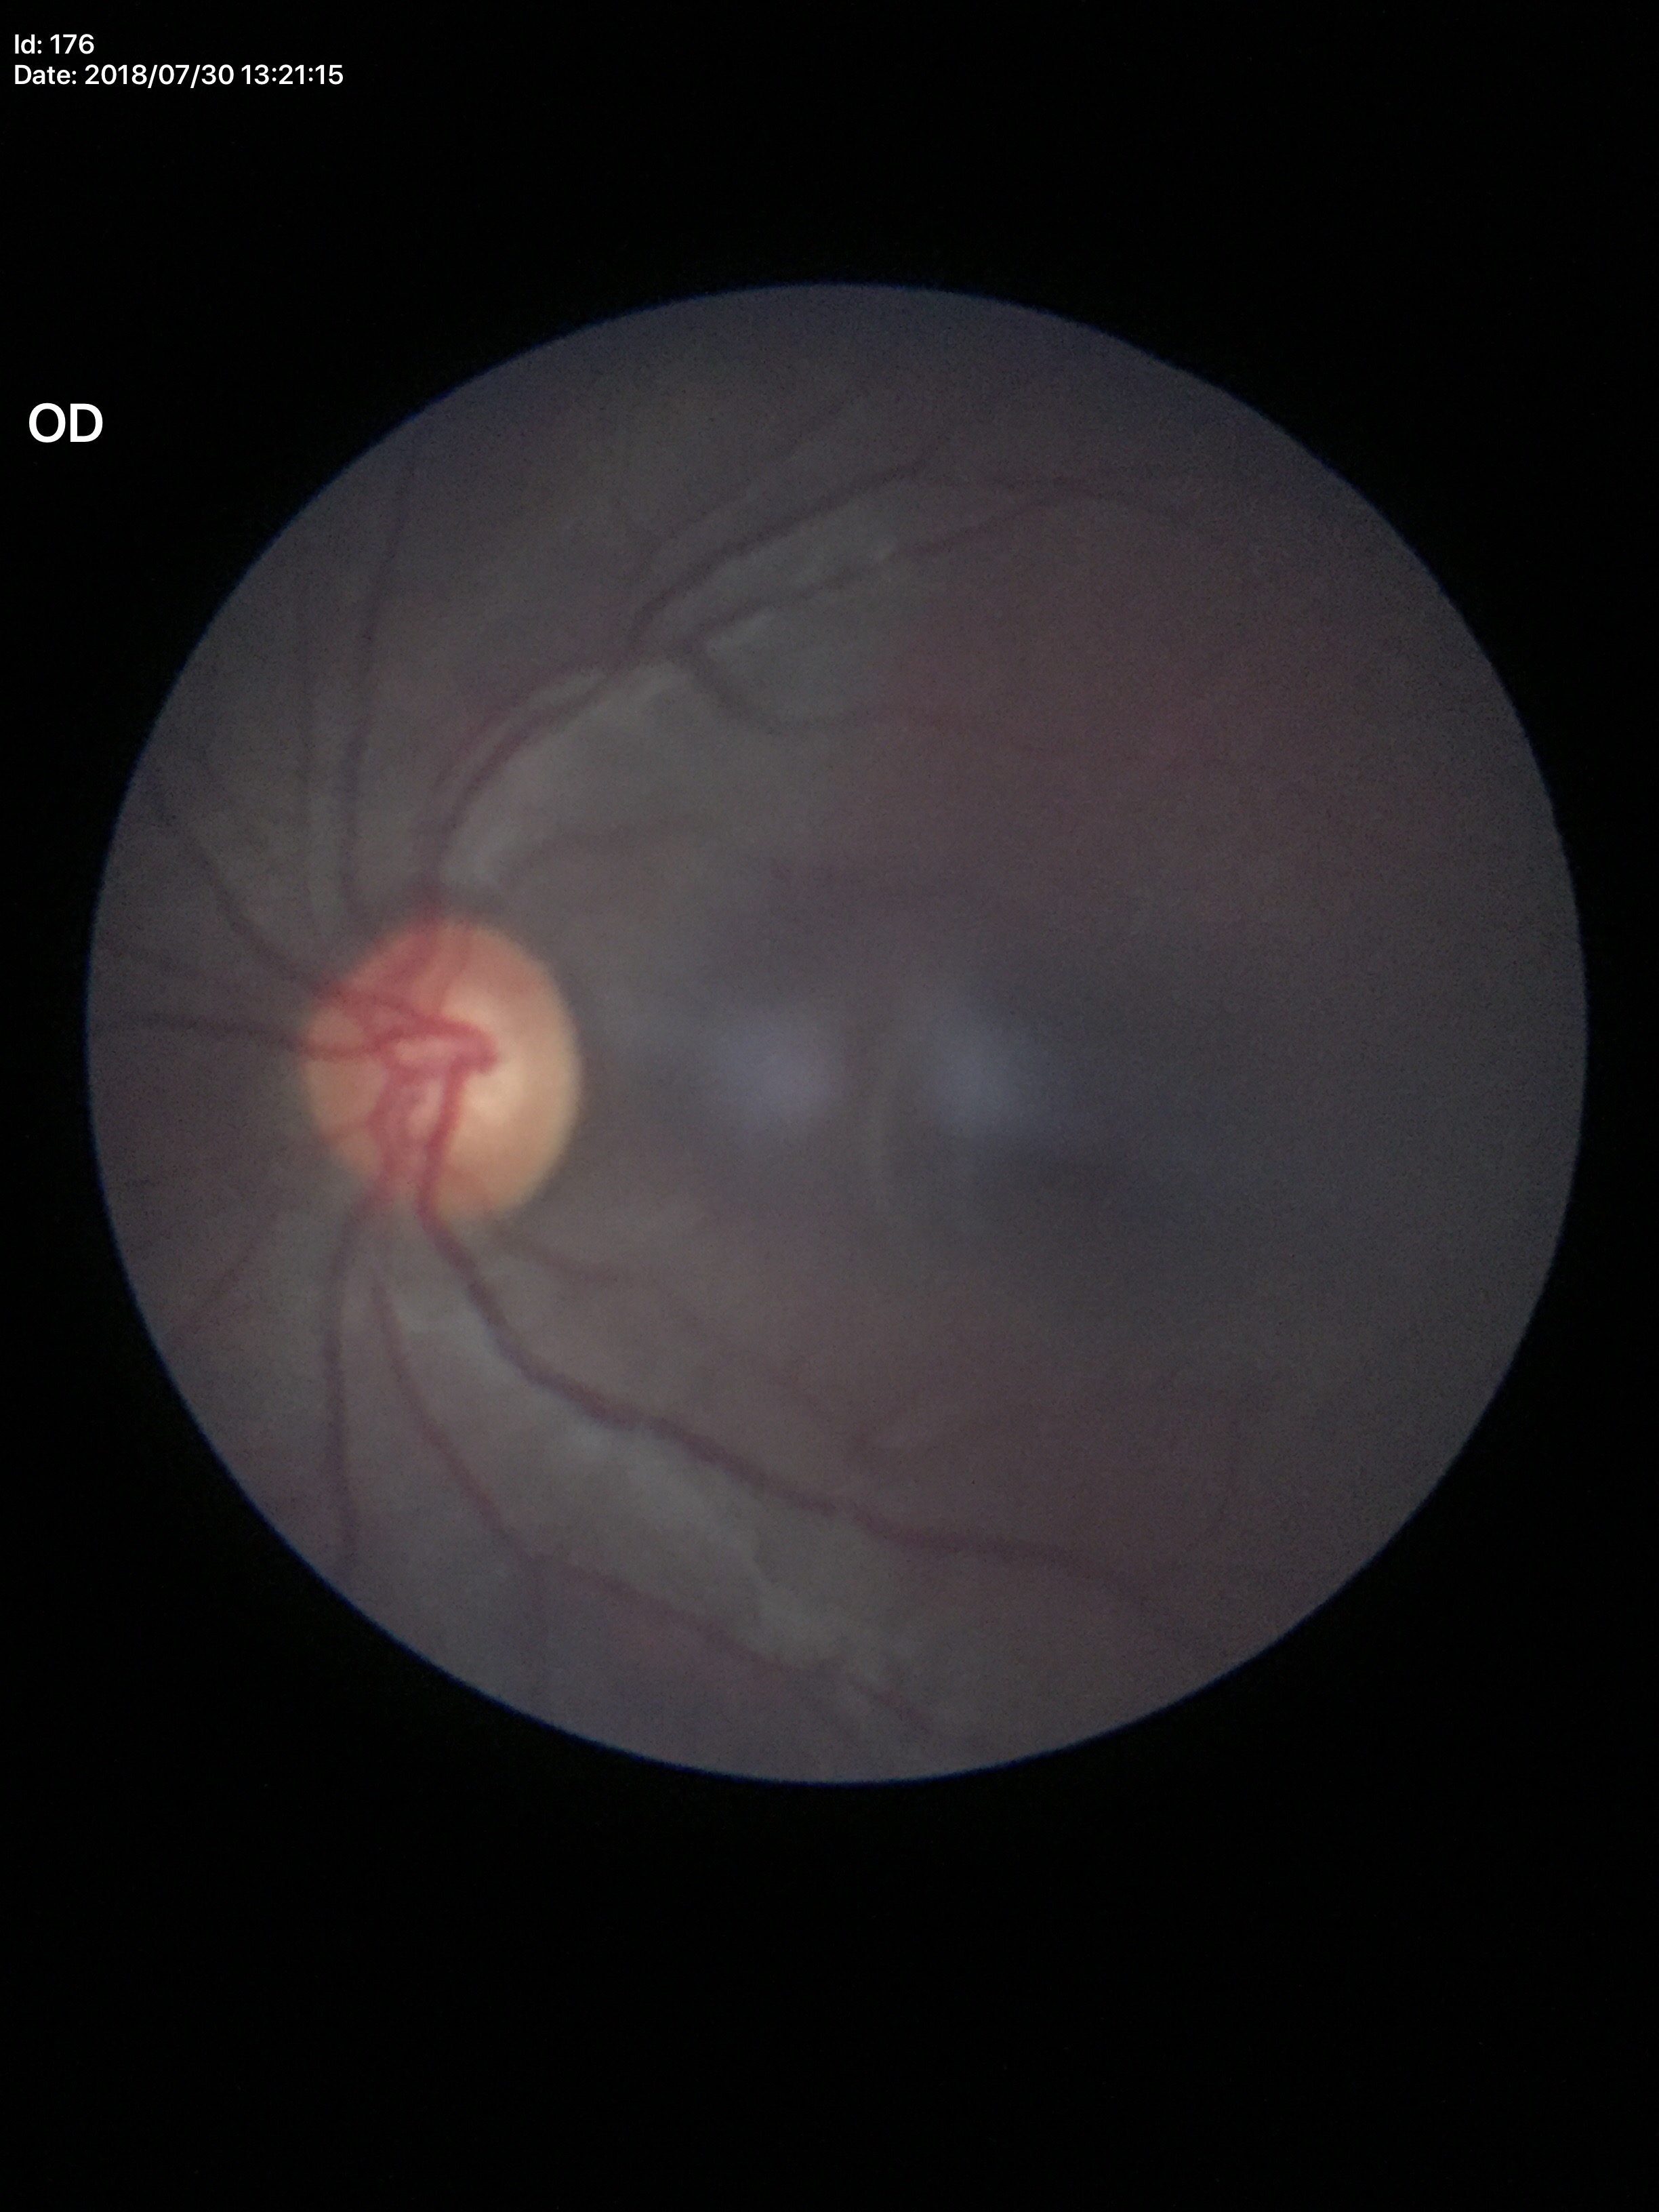 Vertical cup-to-disc ratio (VCDR): 0.58. Glaucoma impression: no suspicious findings (2/5 graders called glaucoma suspect).